Infant wide-field fundus photograph:
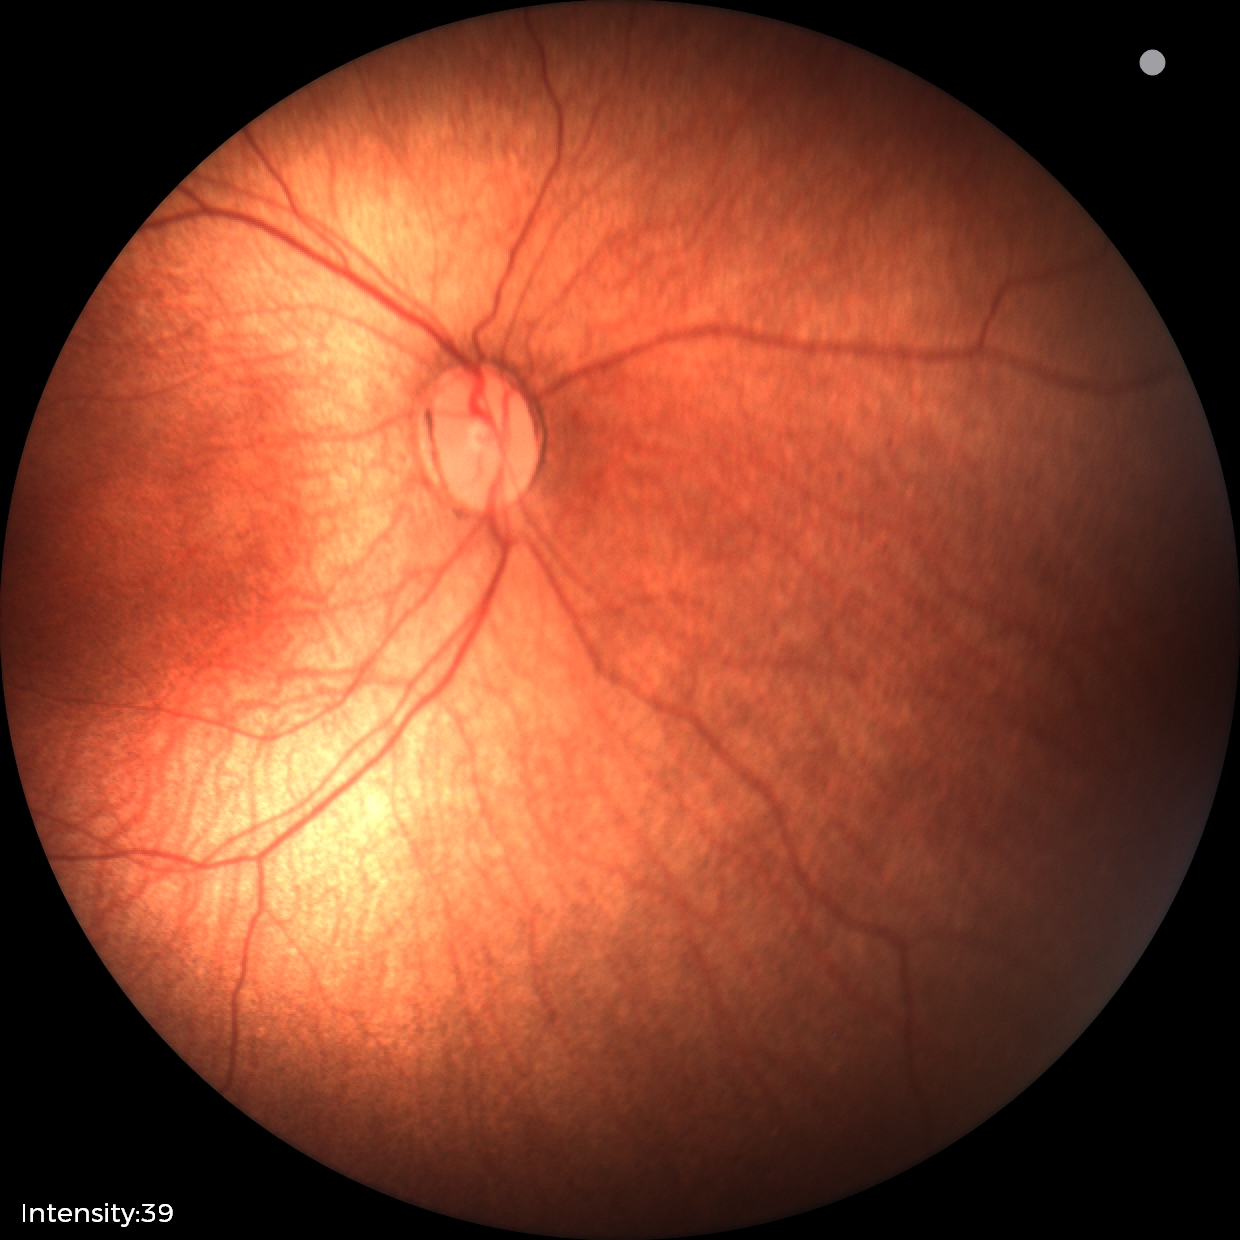

Plus disease absent. Screening series with status post retinopathy of prematurity (ROP) — retinal appearance after treated retinopathy of prematurity.